Captured after pupil dilation:
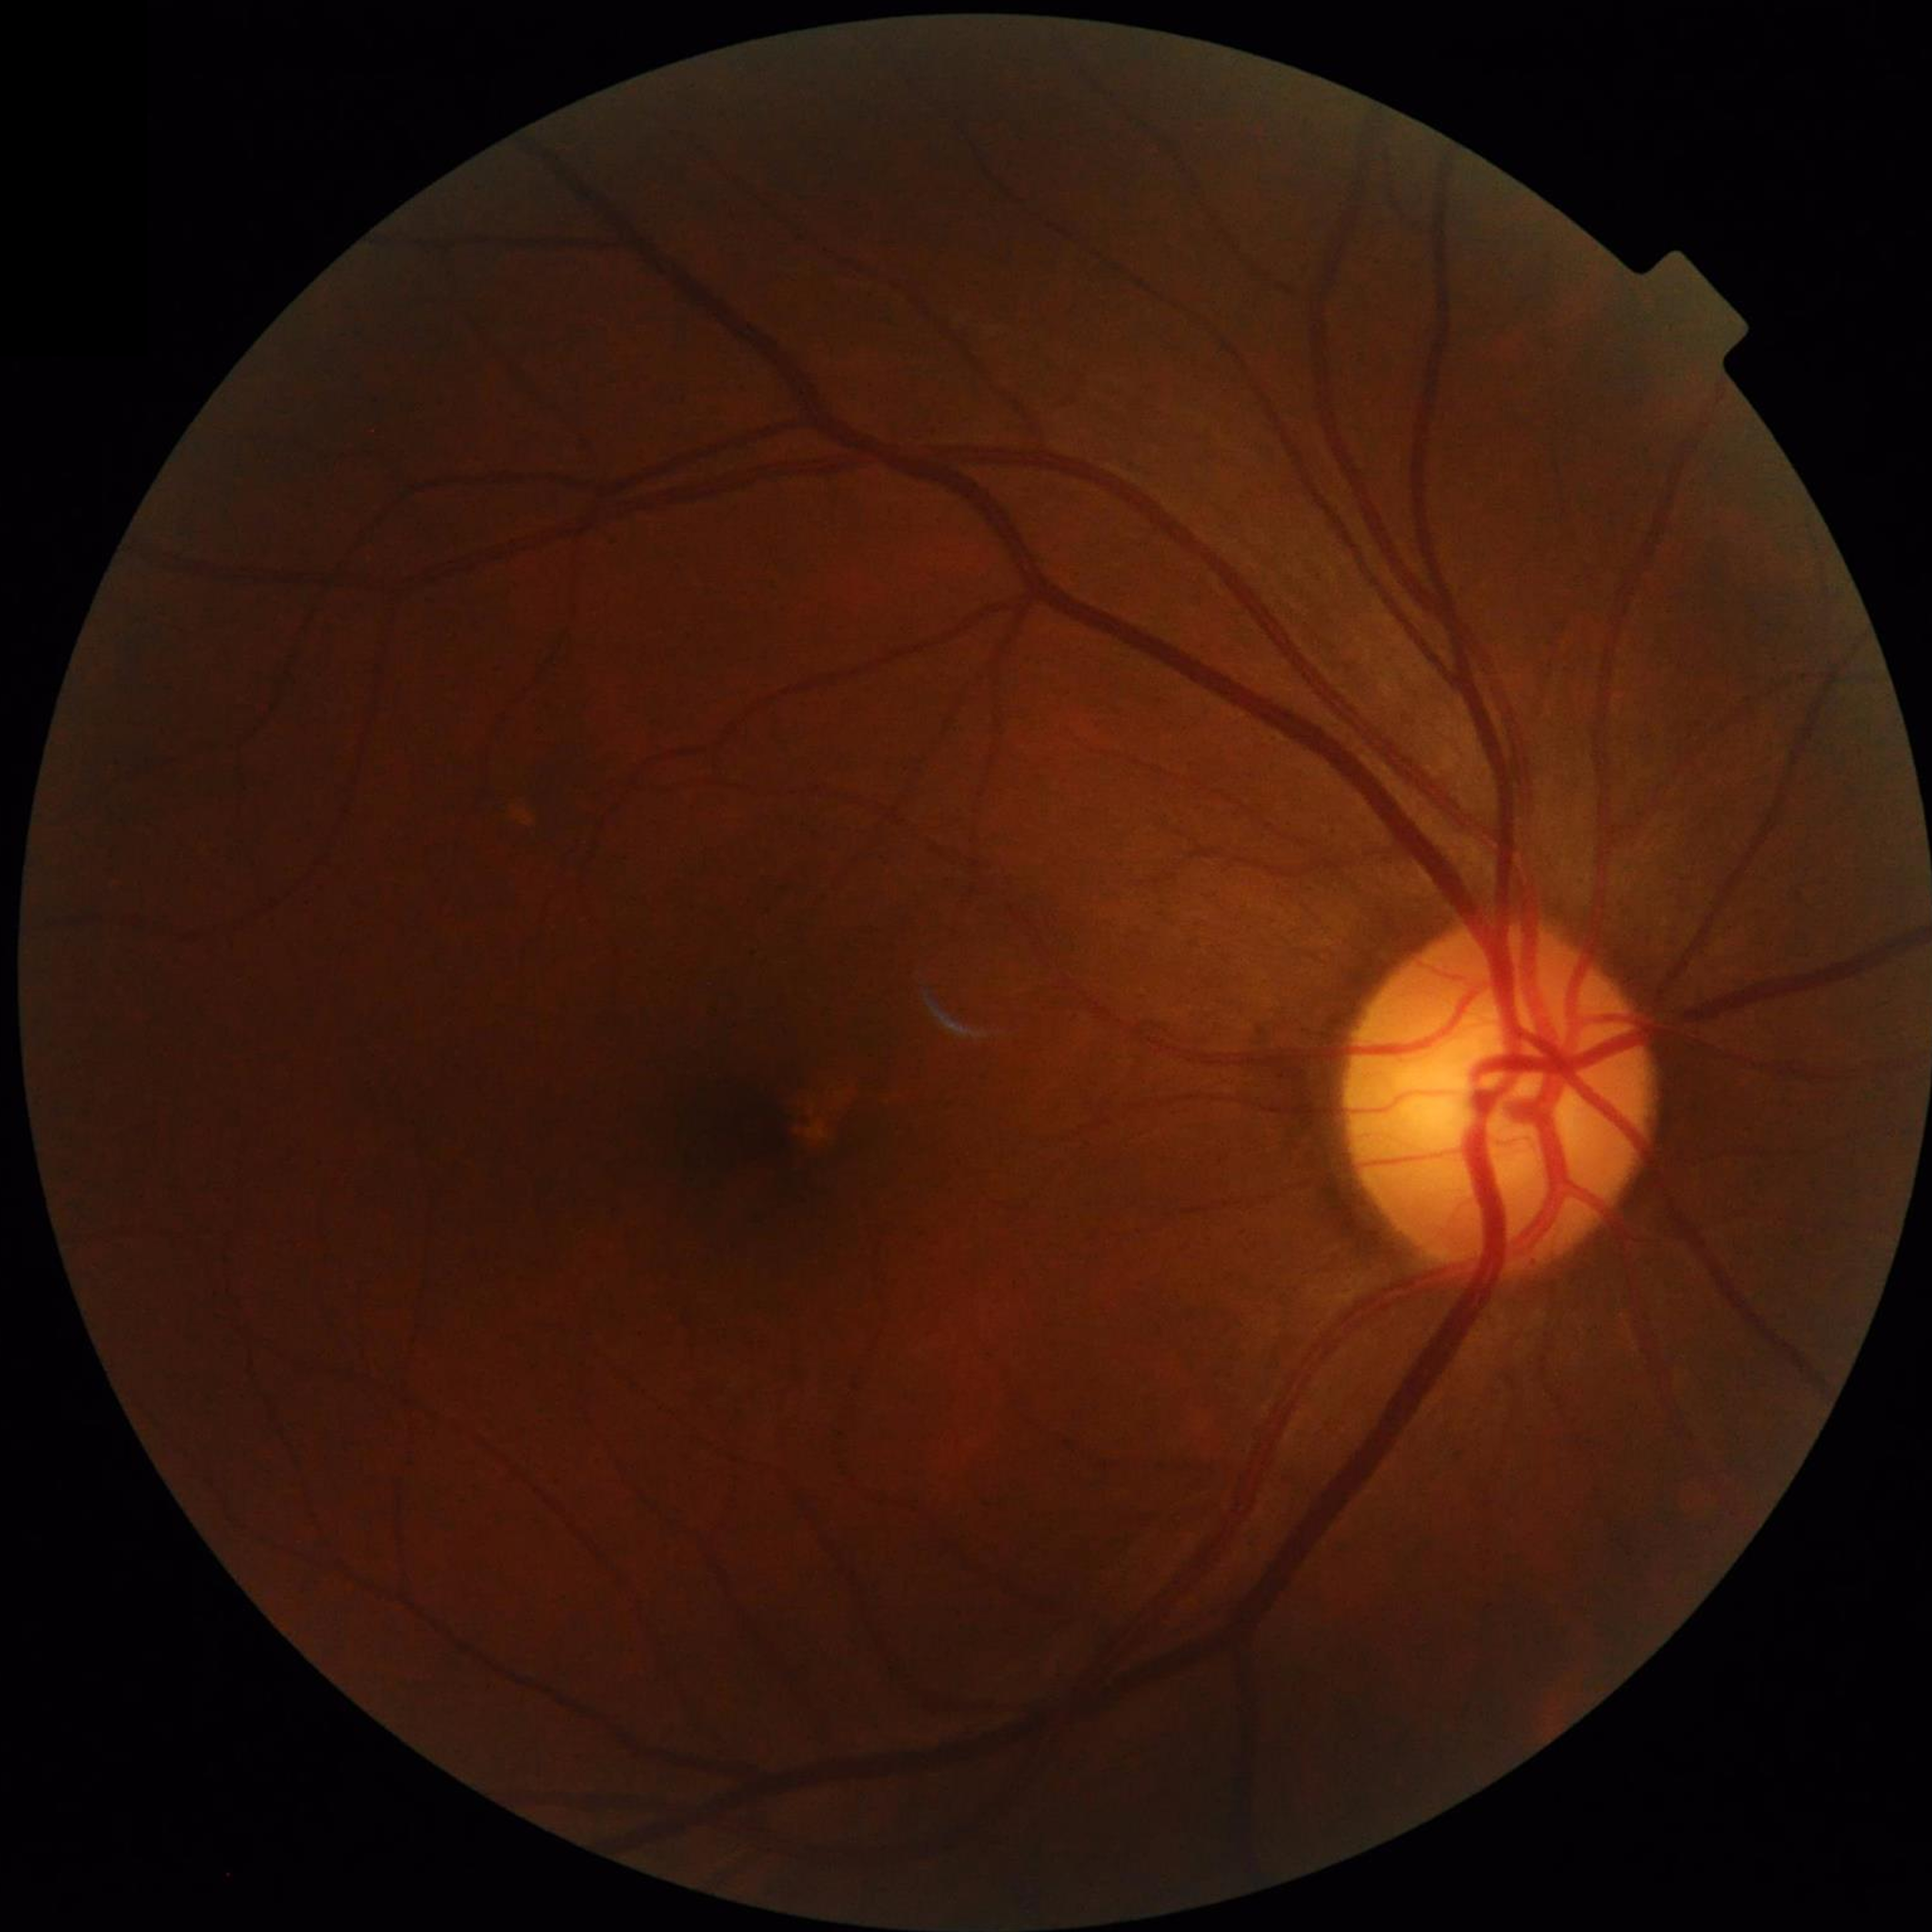

{"diagnosis": "no AMD, DR, or glaucomatous findings", "image_quality": "issues noted — illumination/color distortion"}